FOV: 45 degrees. NIDEK AFC-230 fundus camera. CFP.
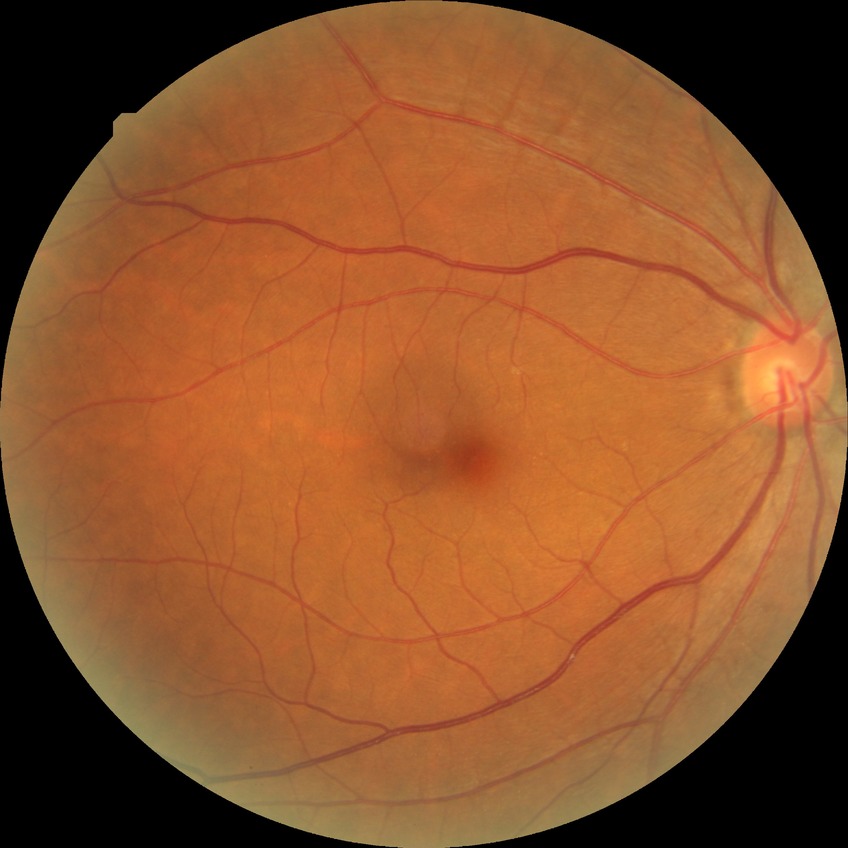
Findings:
• DR impression: negative for DR
• DR grade: NDR